Acquired on the Phoenix ICON; 1240x1240px; pediatric retinal photograph (wide-field)
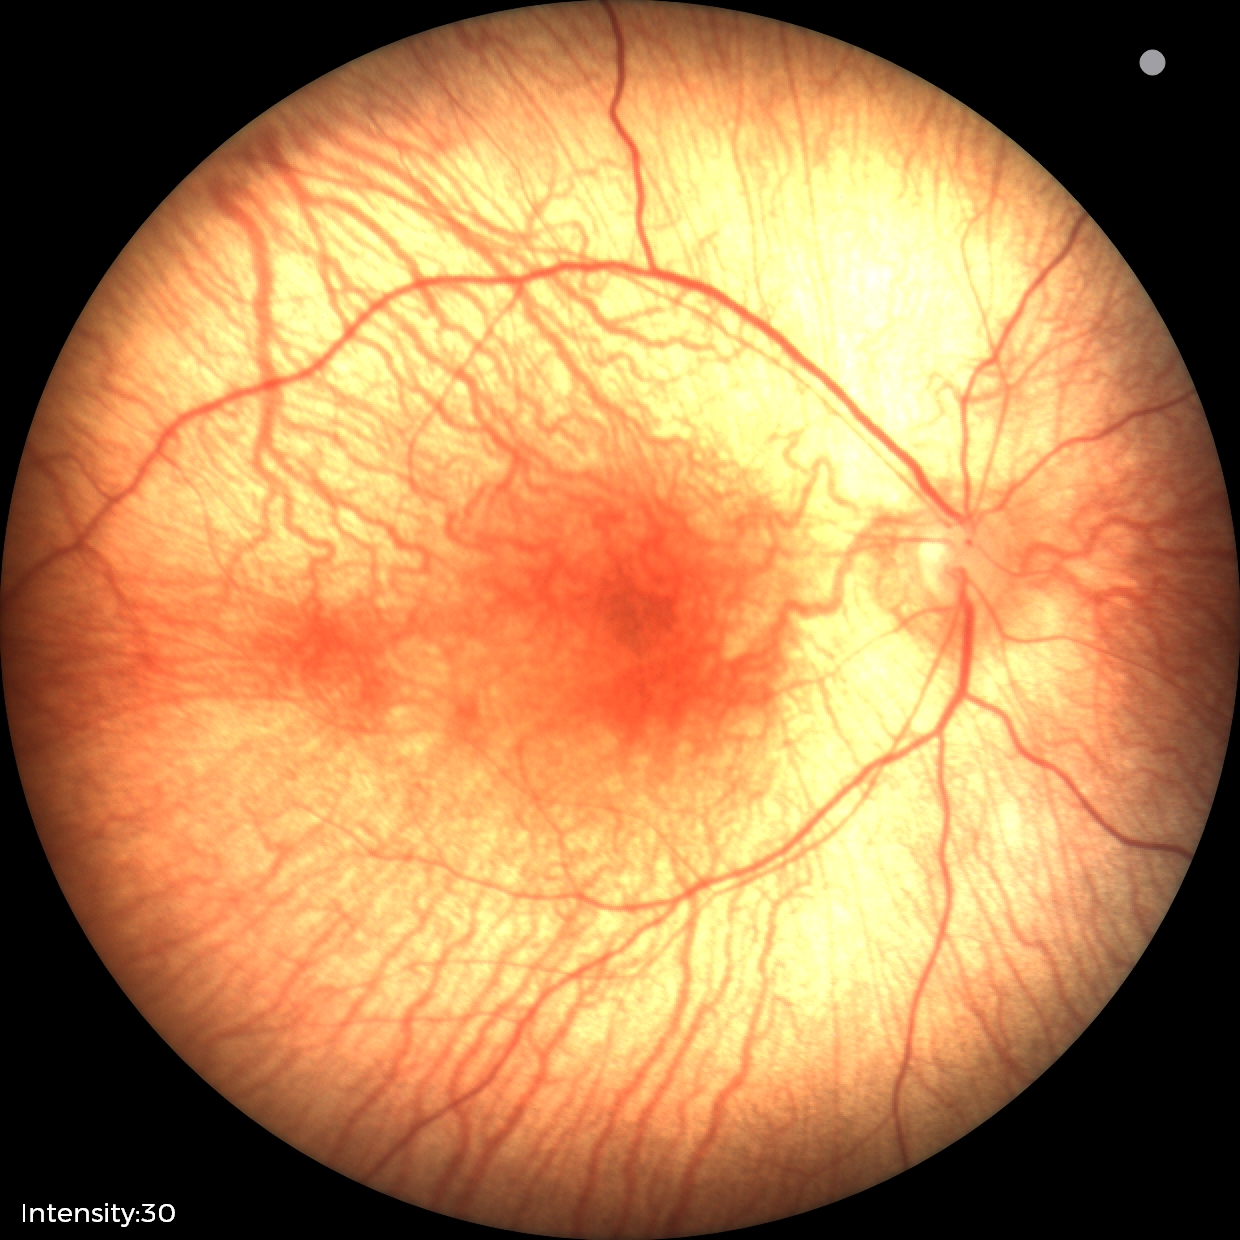
Screening examination with no abnormal retinal findings.